Captured on a Nidek AFC-330 fundus camera, color fundus photograph, non-mydriatic fundus camera.
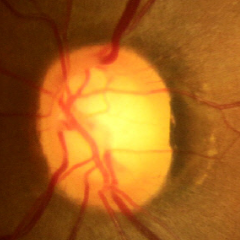

Impression = no glaucoma.